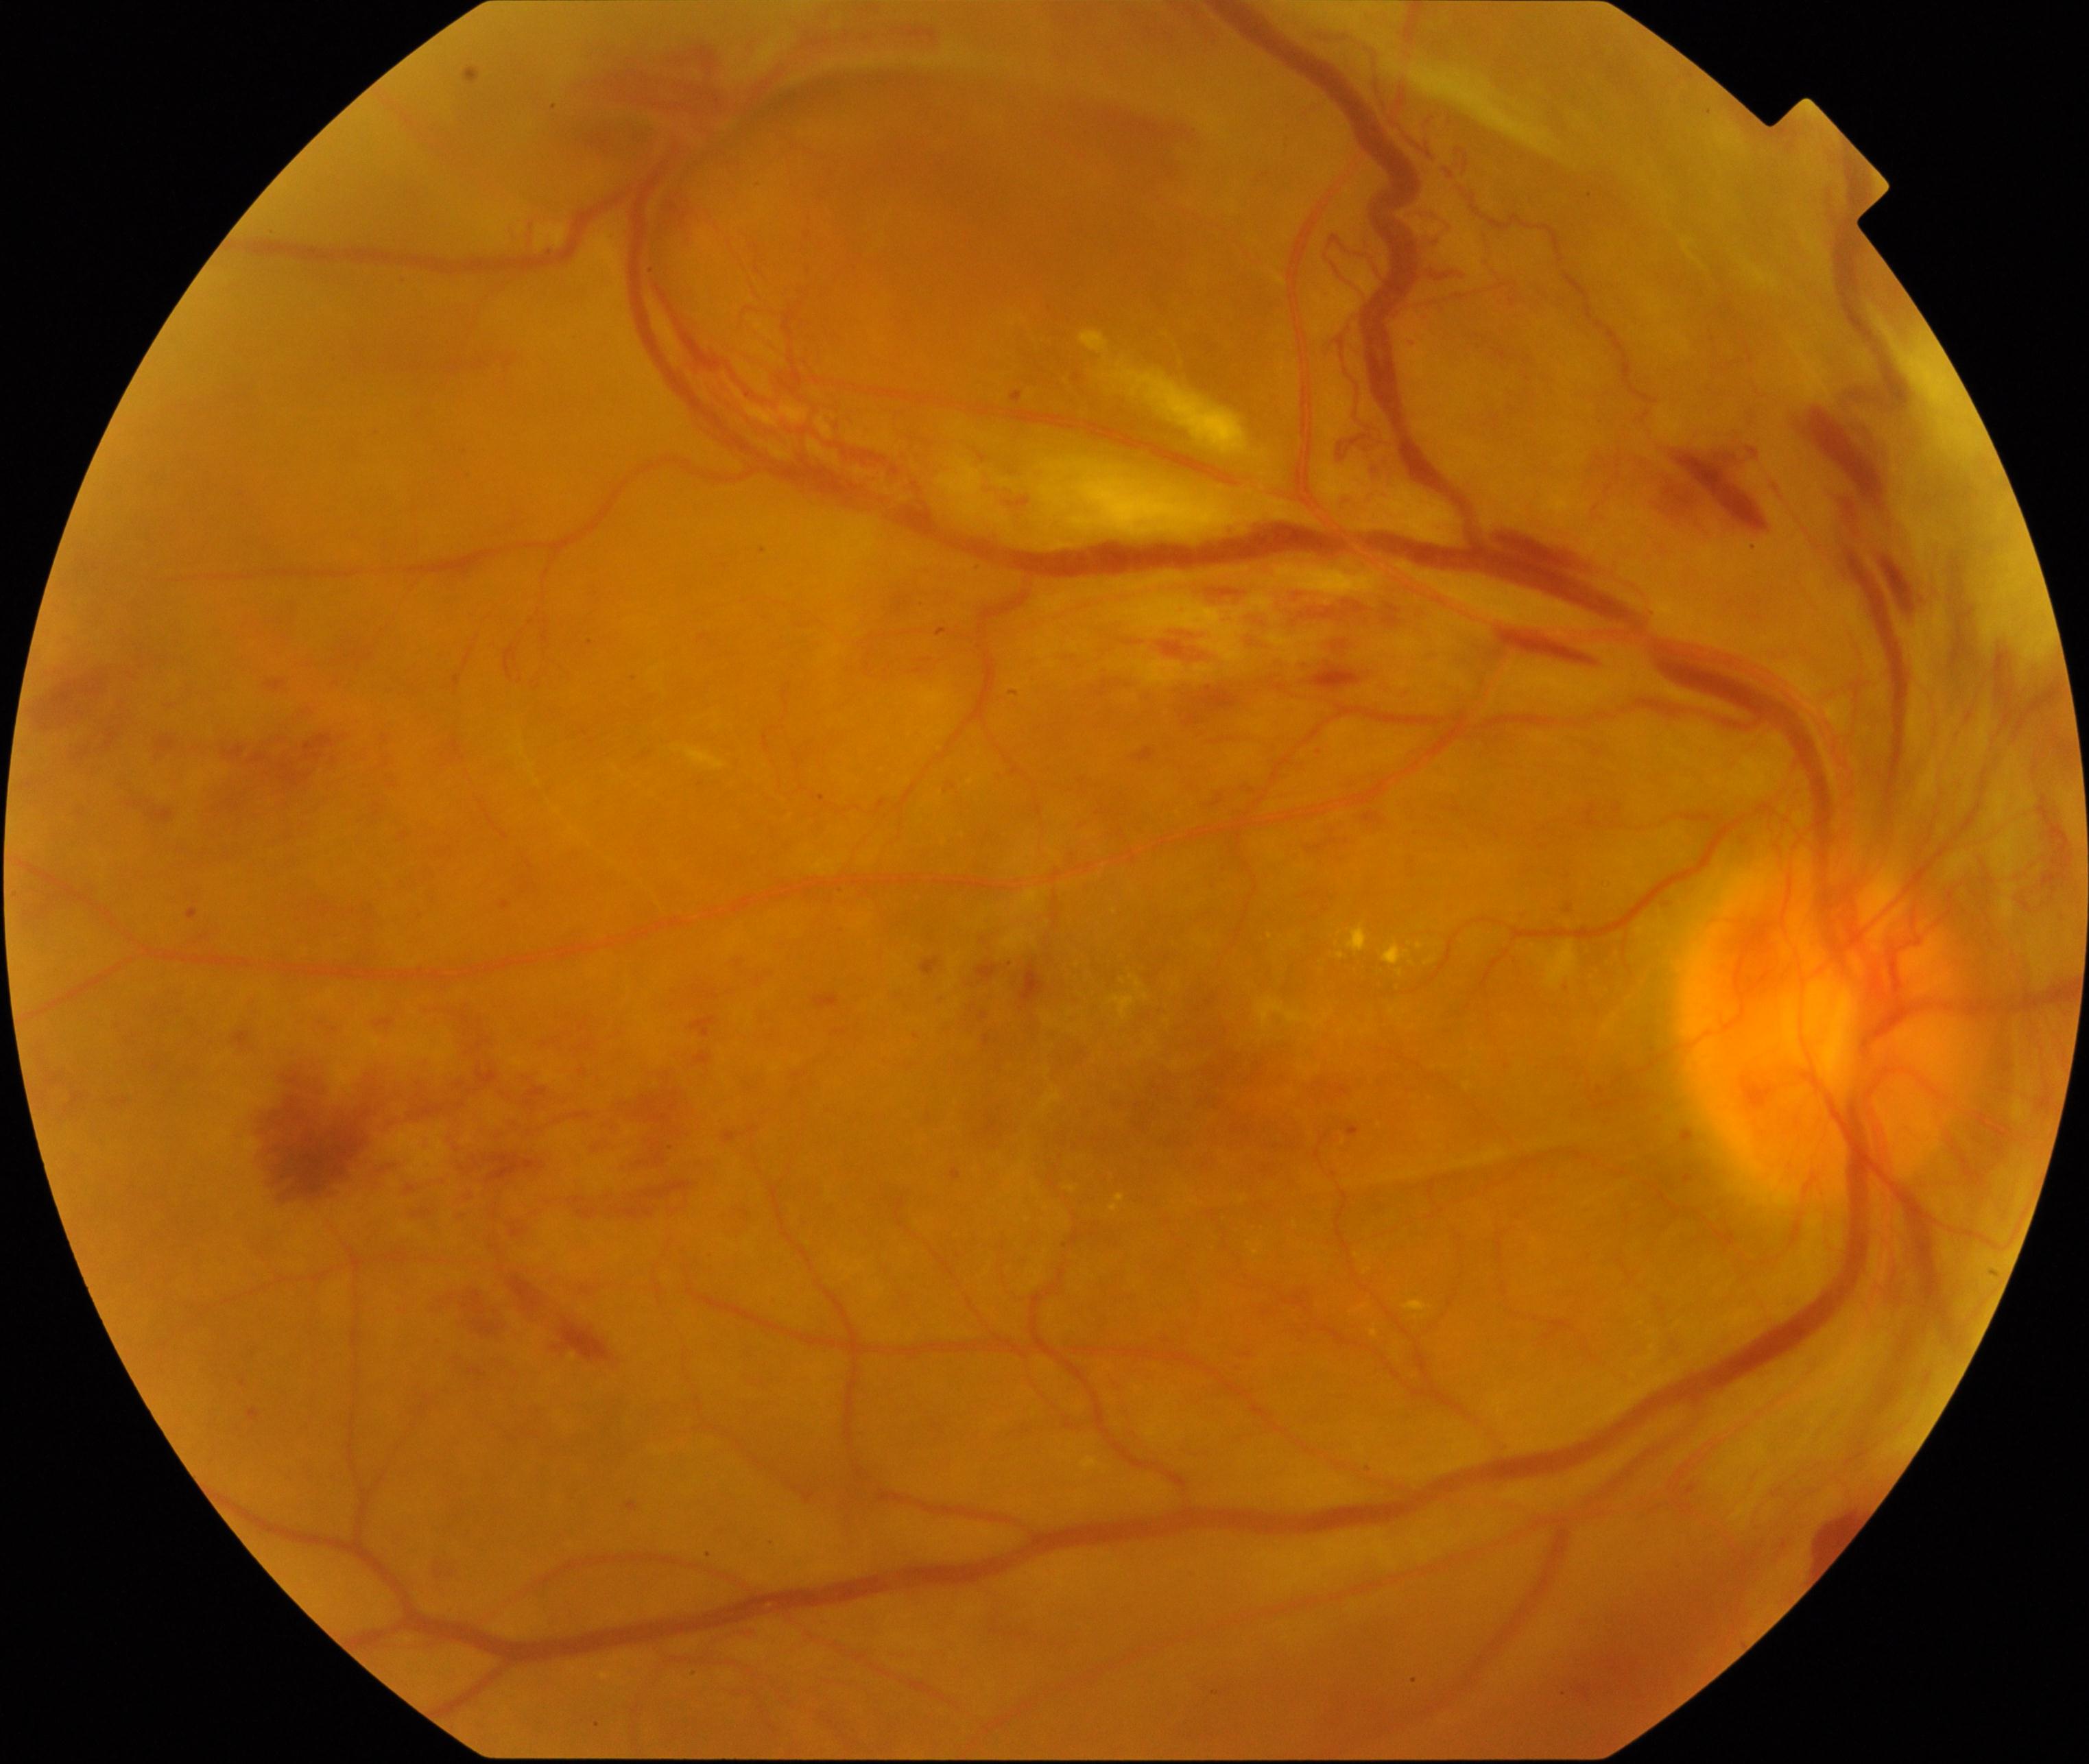
Classification: severe non-proliferative or proliferative diabetic retinopathy.